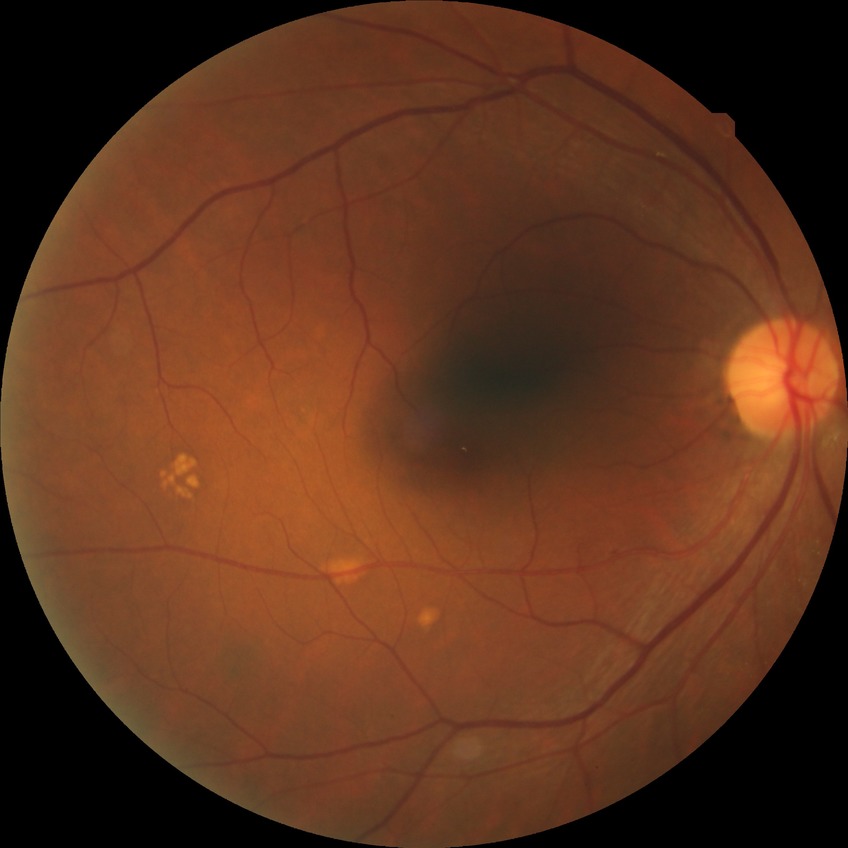
Retinopathy grade is simple diabetic retinopathy.